Fundus photo · FOV: 45 degrees
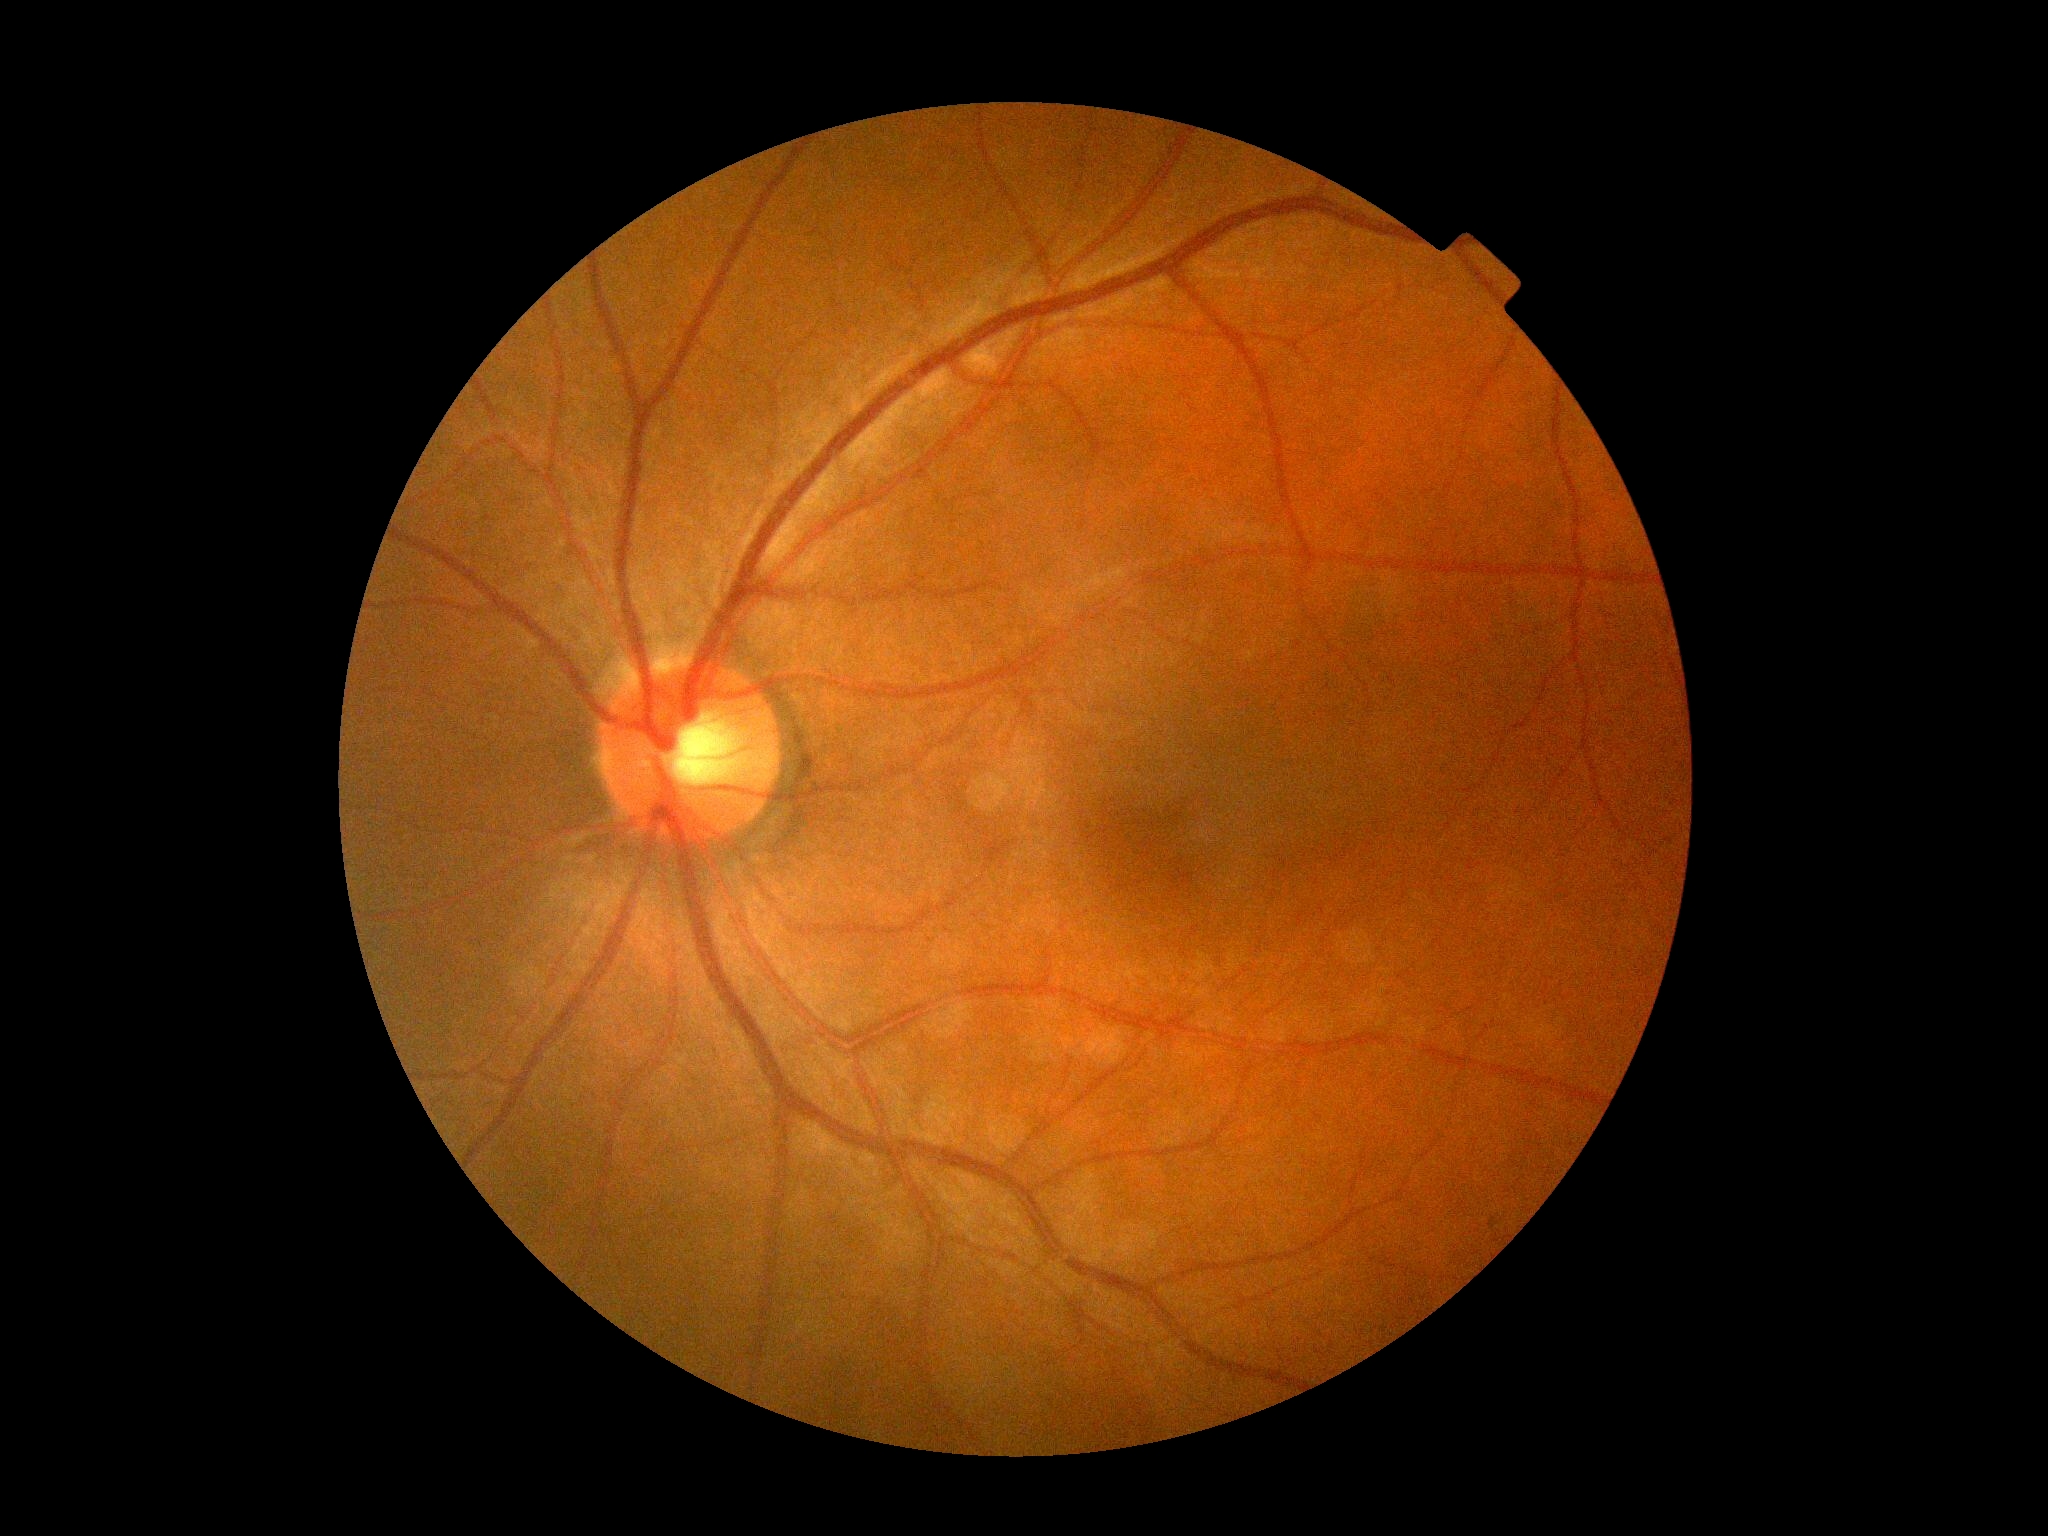

retinopathy grade = no apparent diabetic retinopathy (0) | DR impression = no apparent DR.